Retinal fundus photograph — 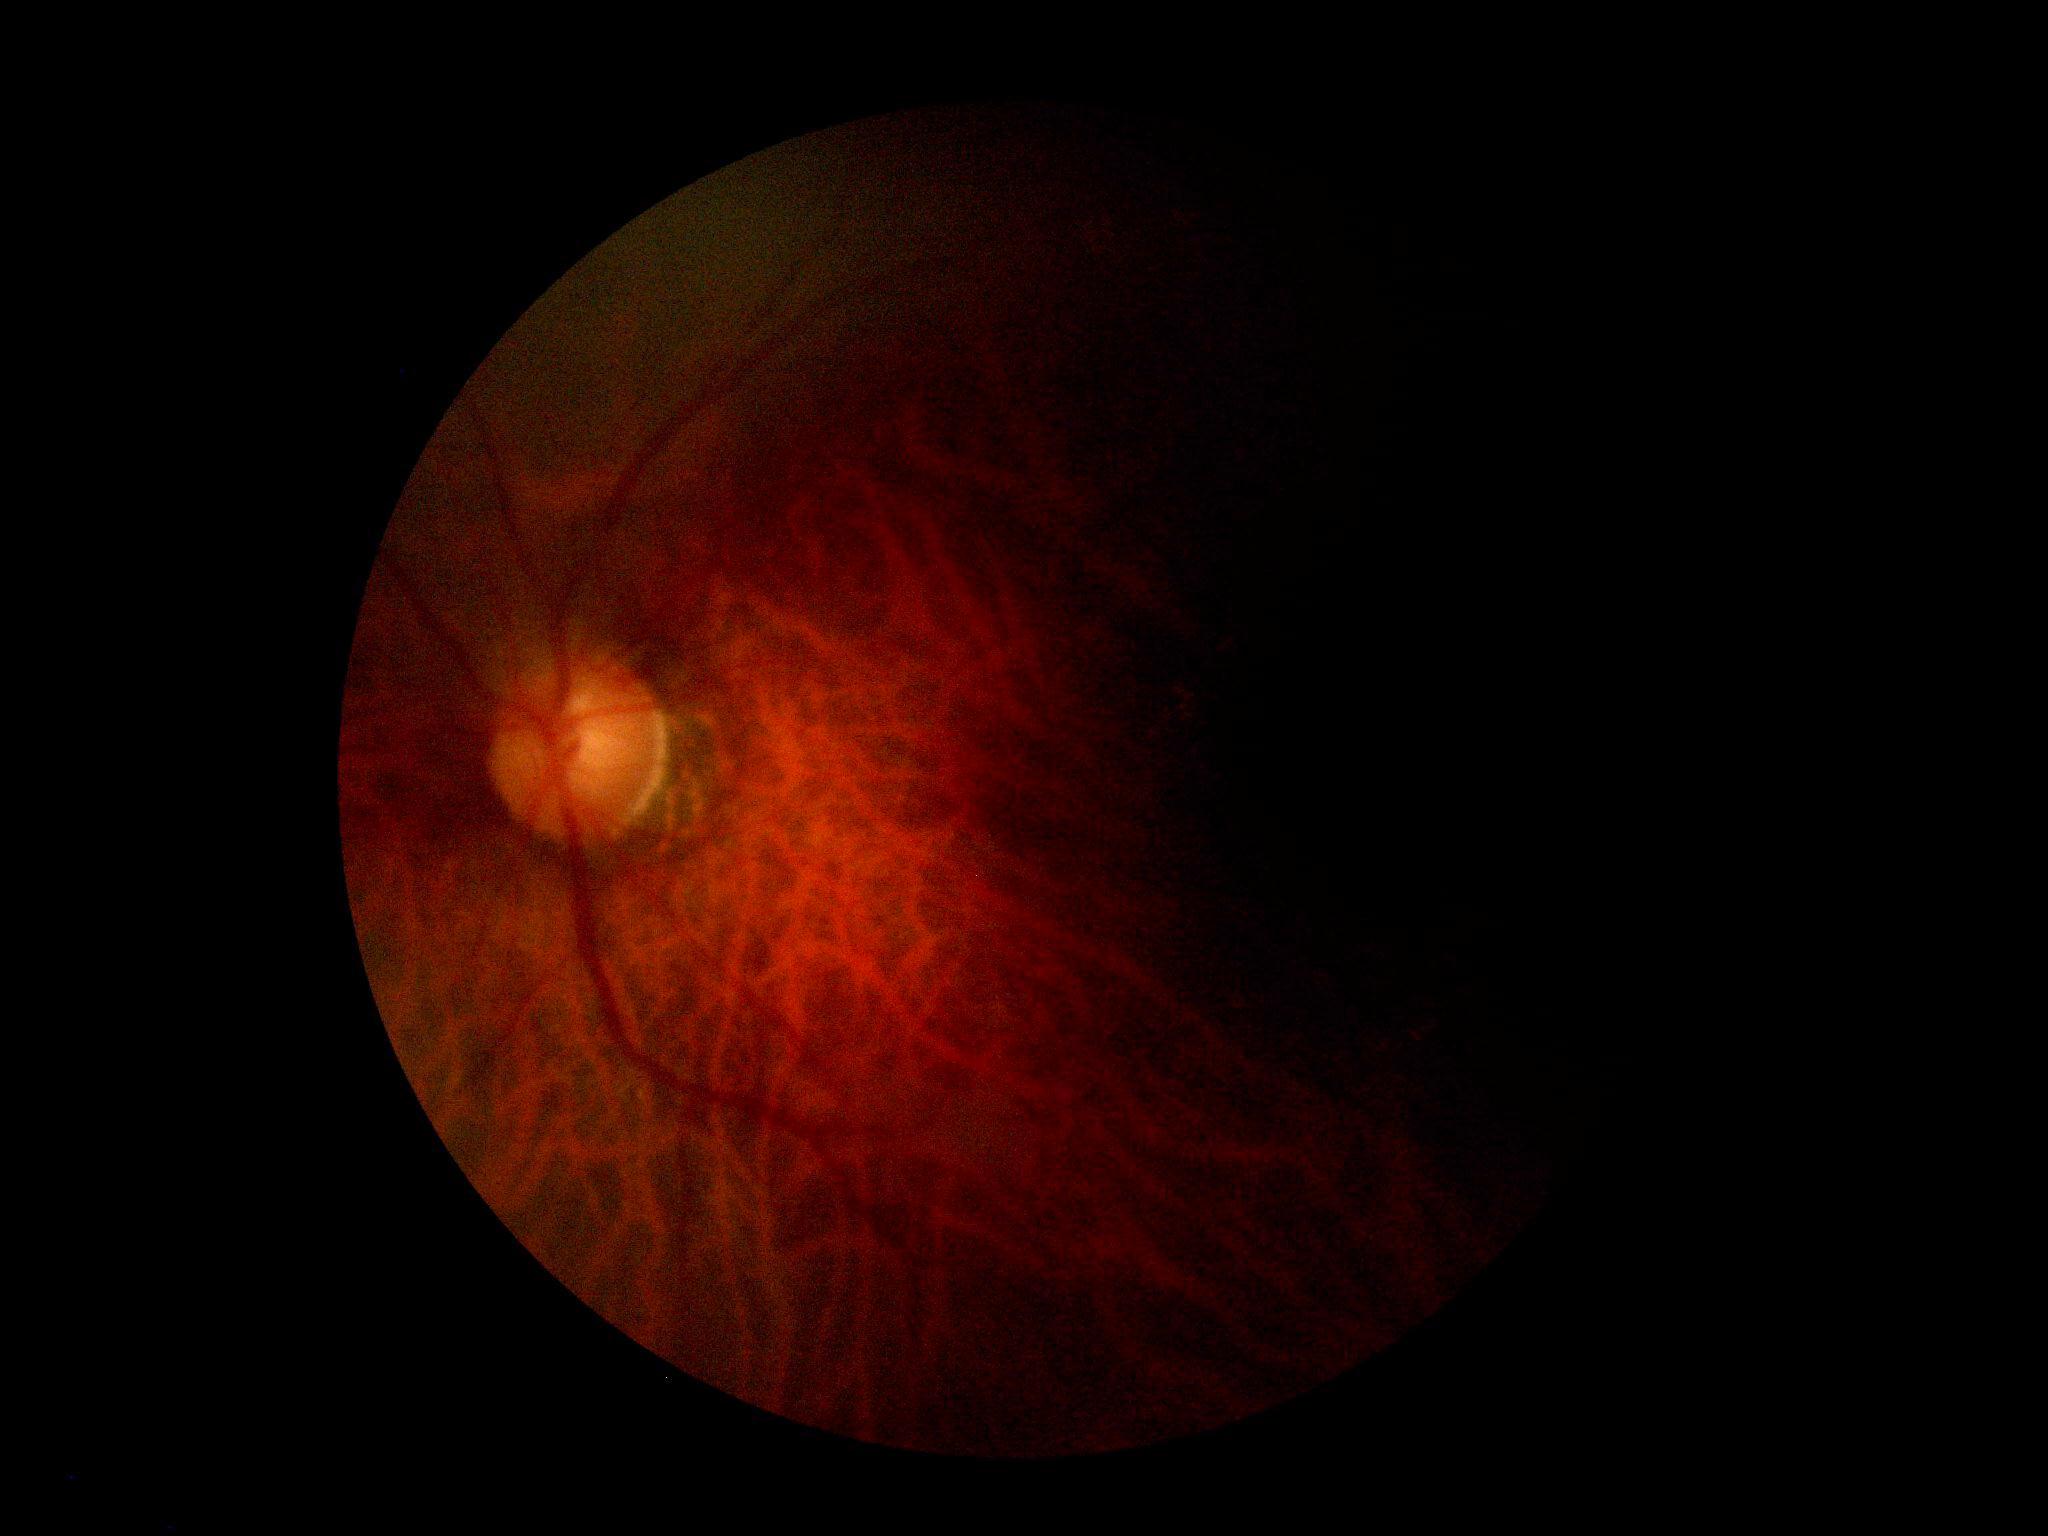 {"quality": "insufficient for DR assessment", "dr_grade": "ungradable"}